No pharmacologic dilation — 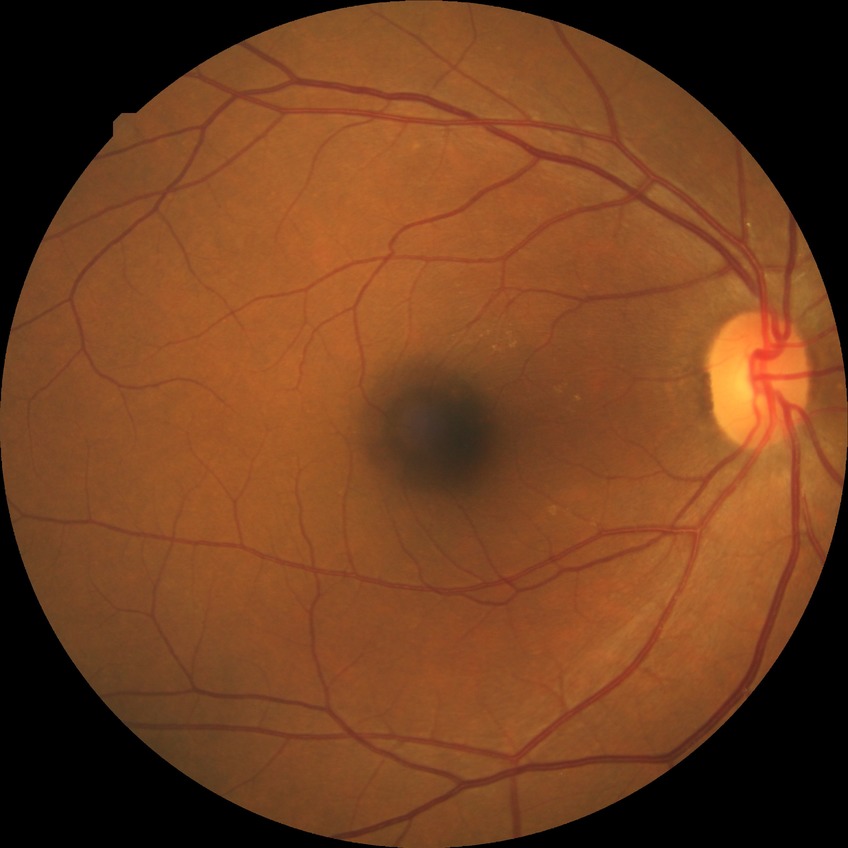 retinopathy grade = no diabetic retinopathy.